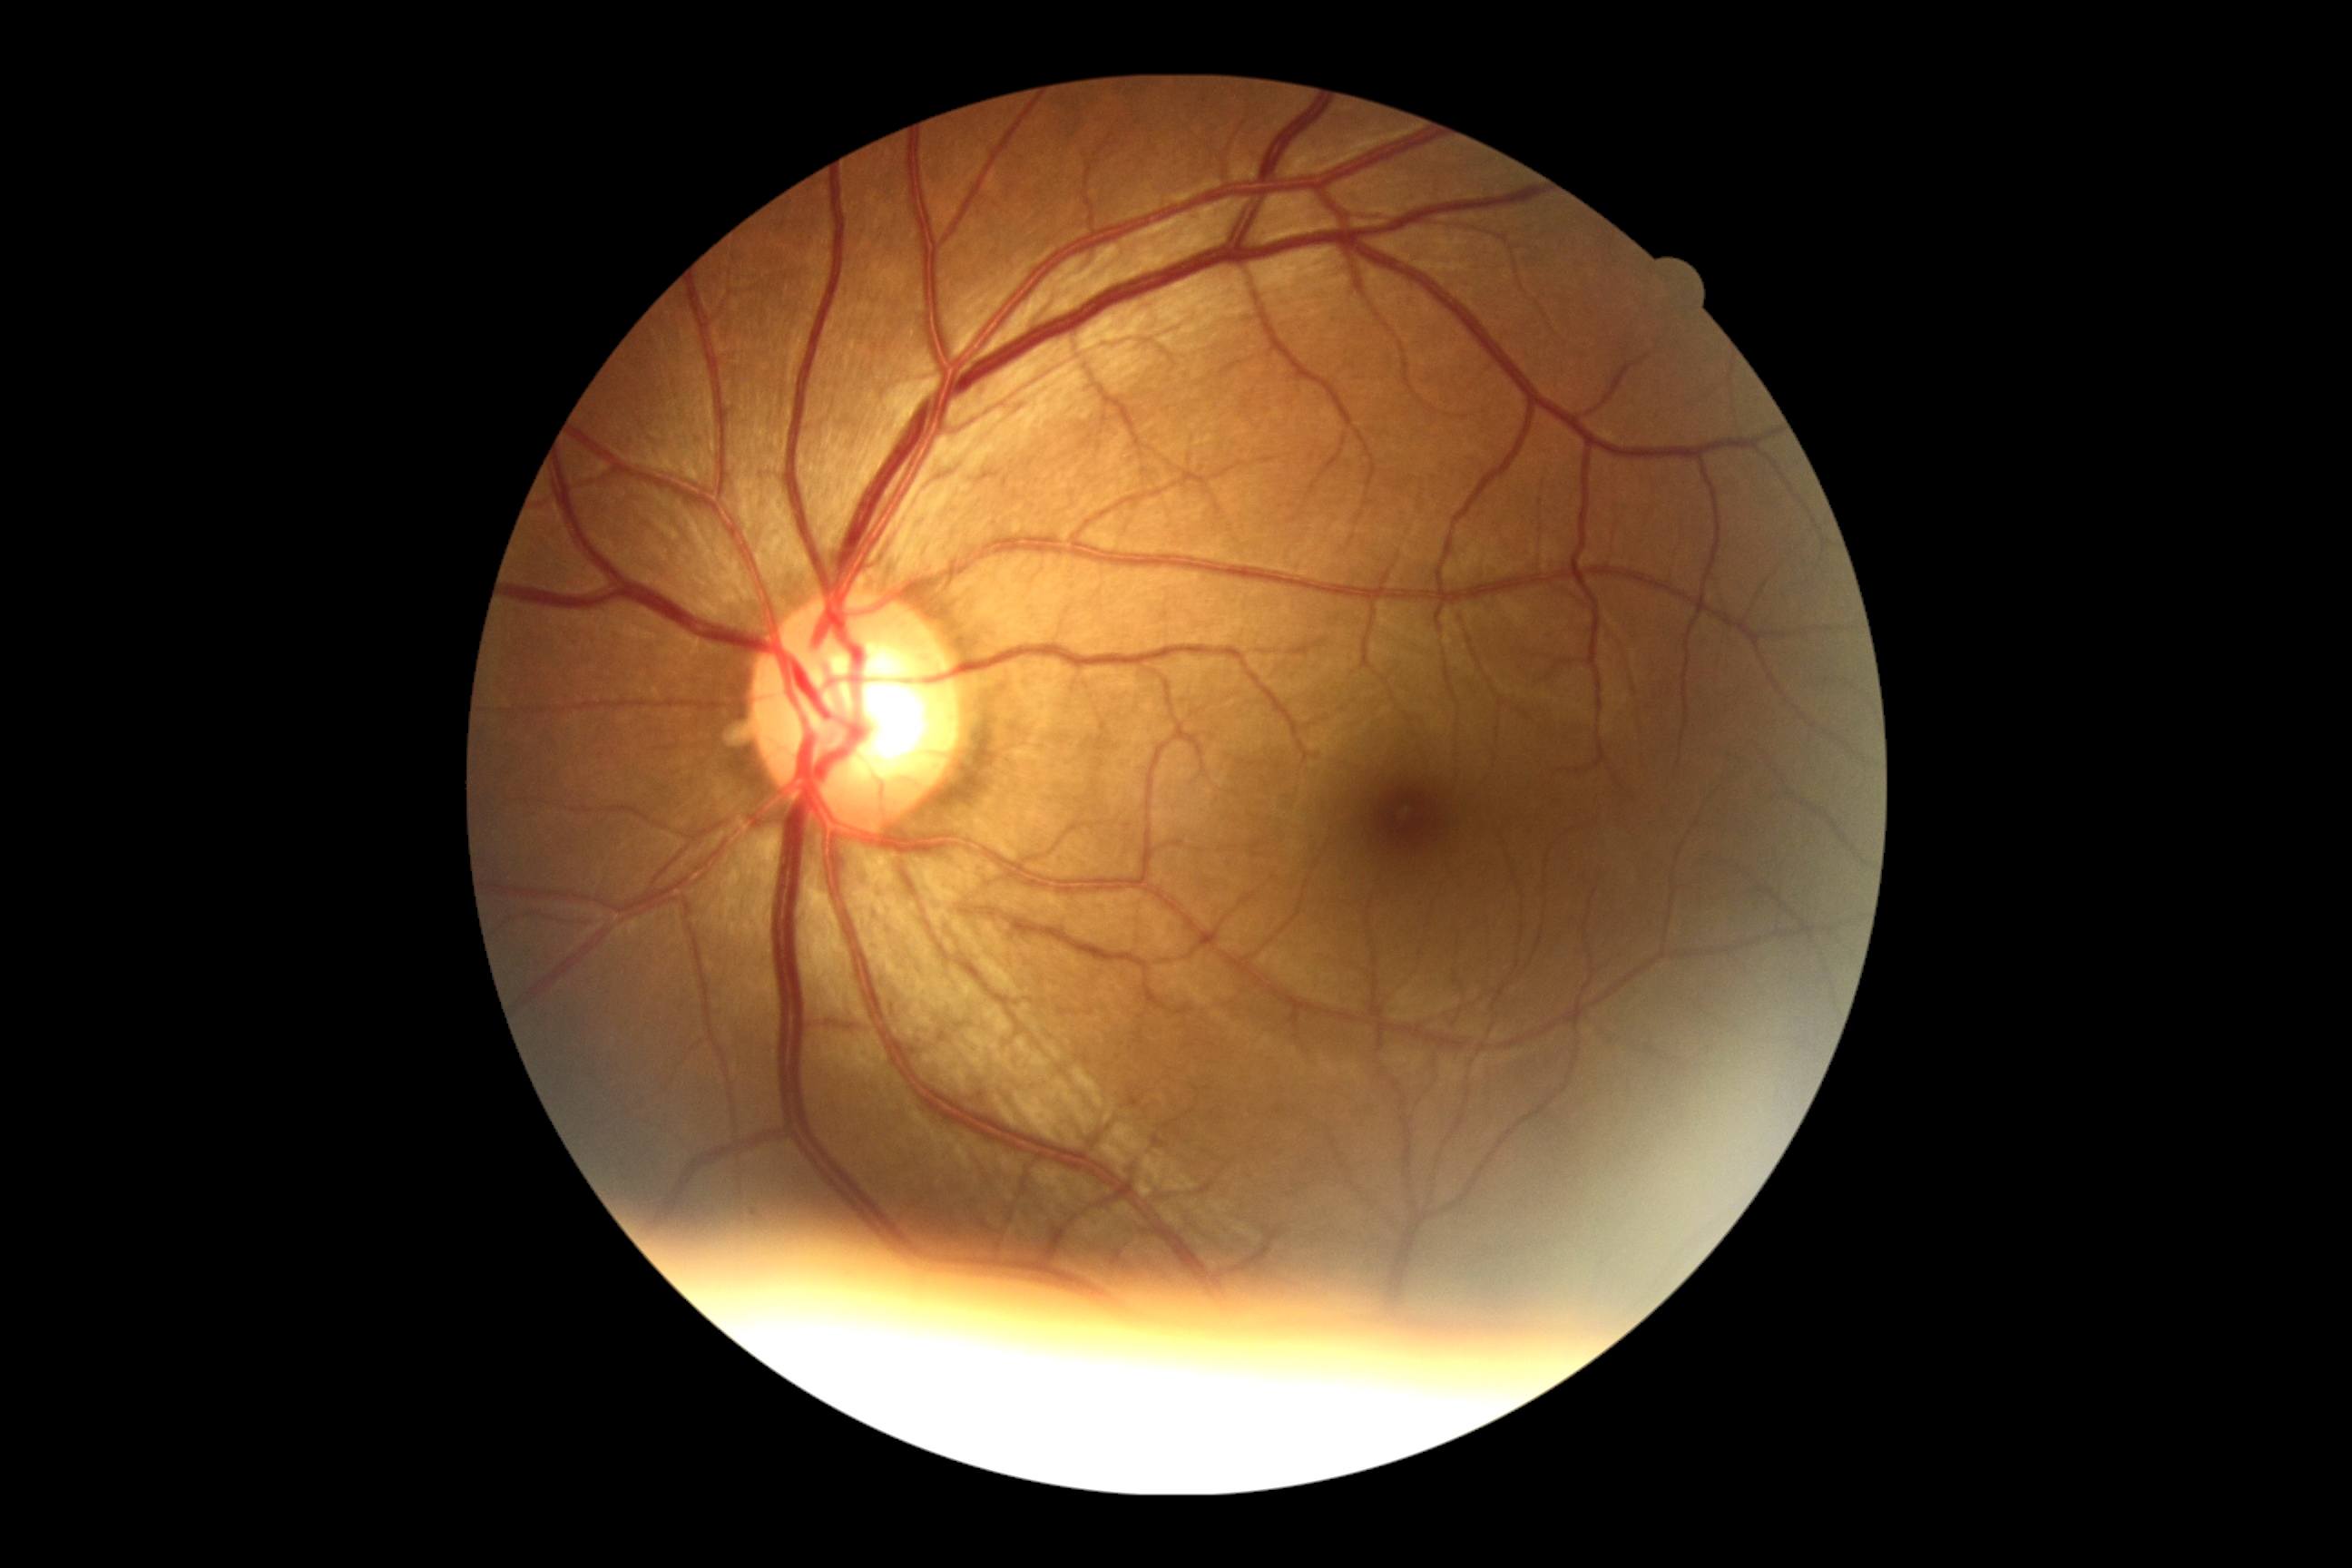
diabetic retinopathy grade: 0, DR impression: no signs of DR.